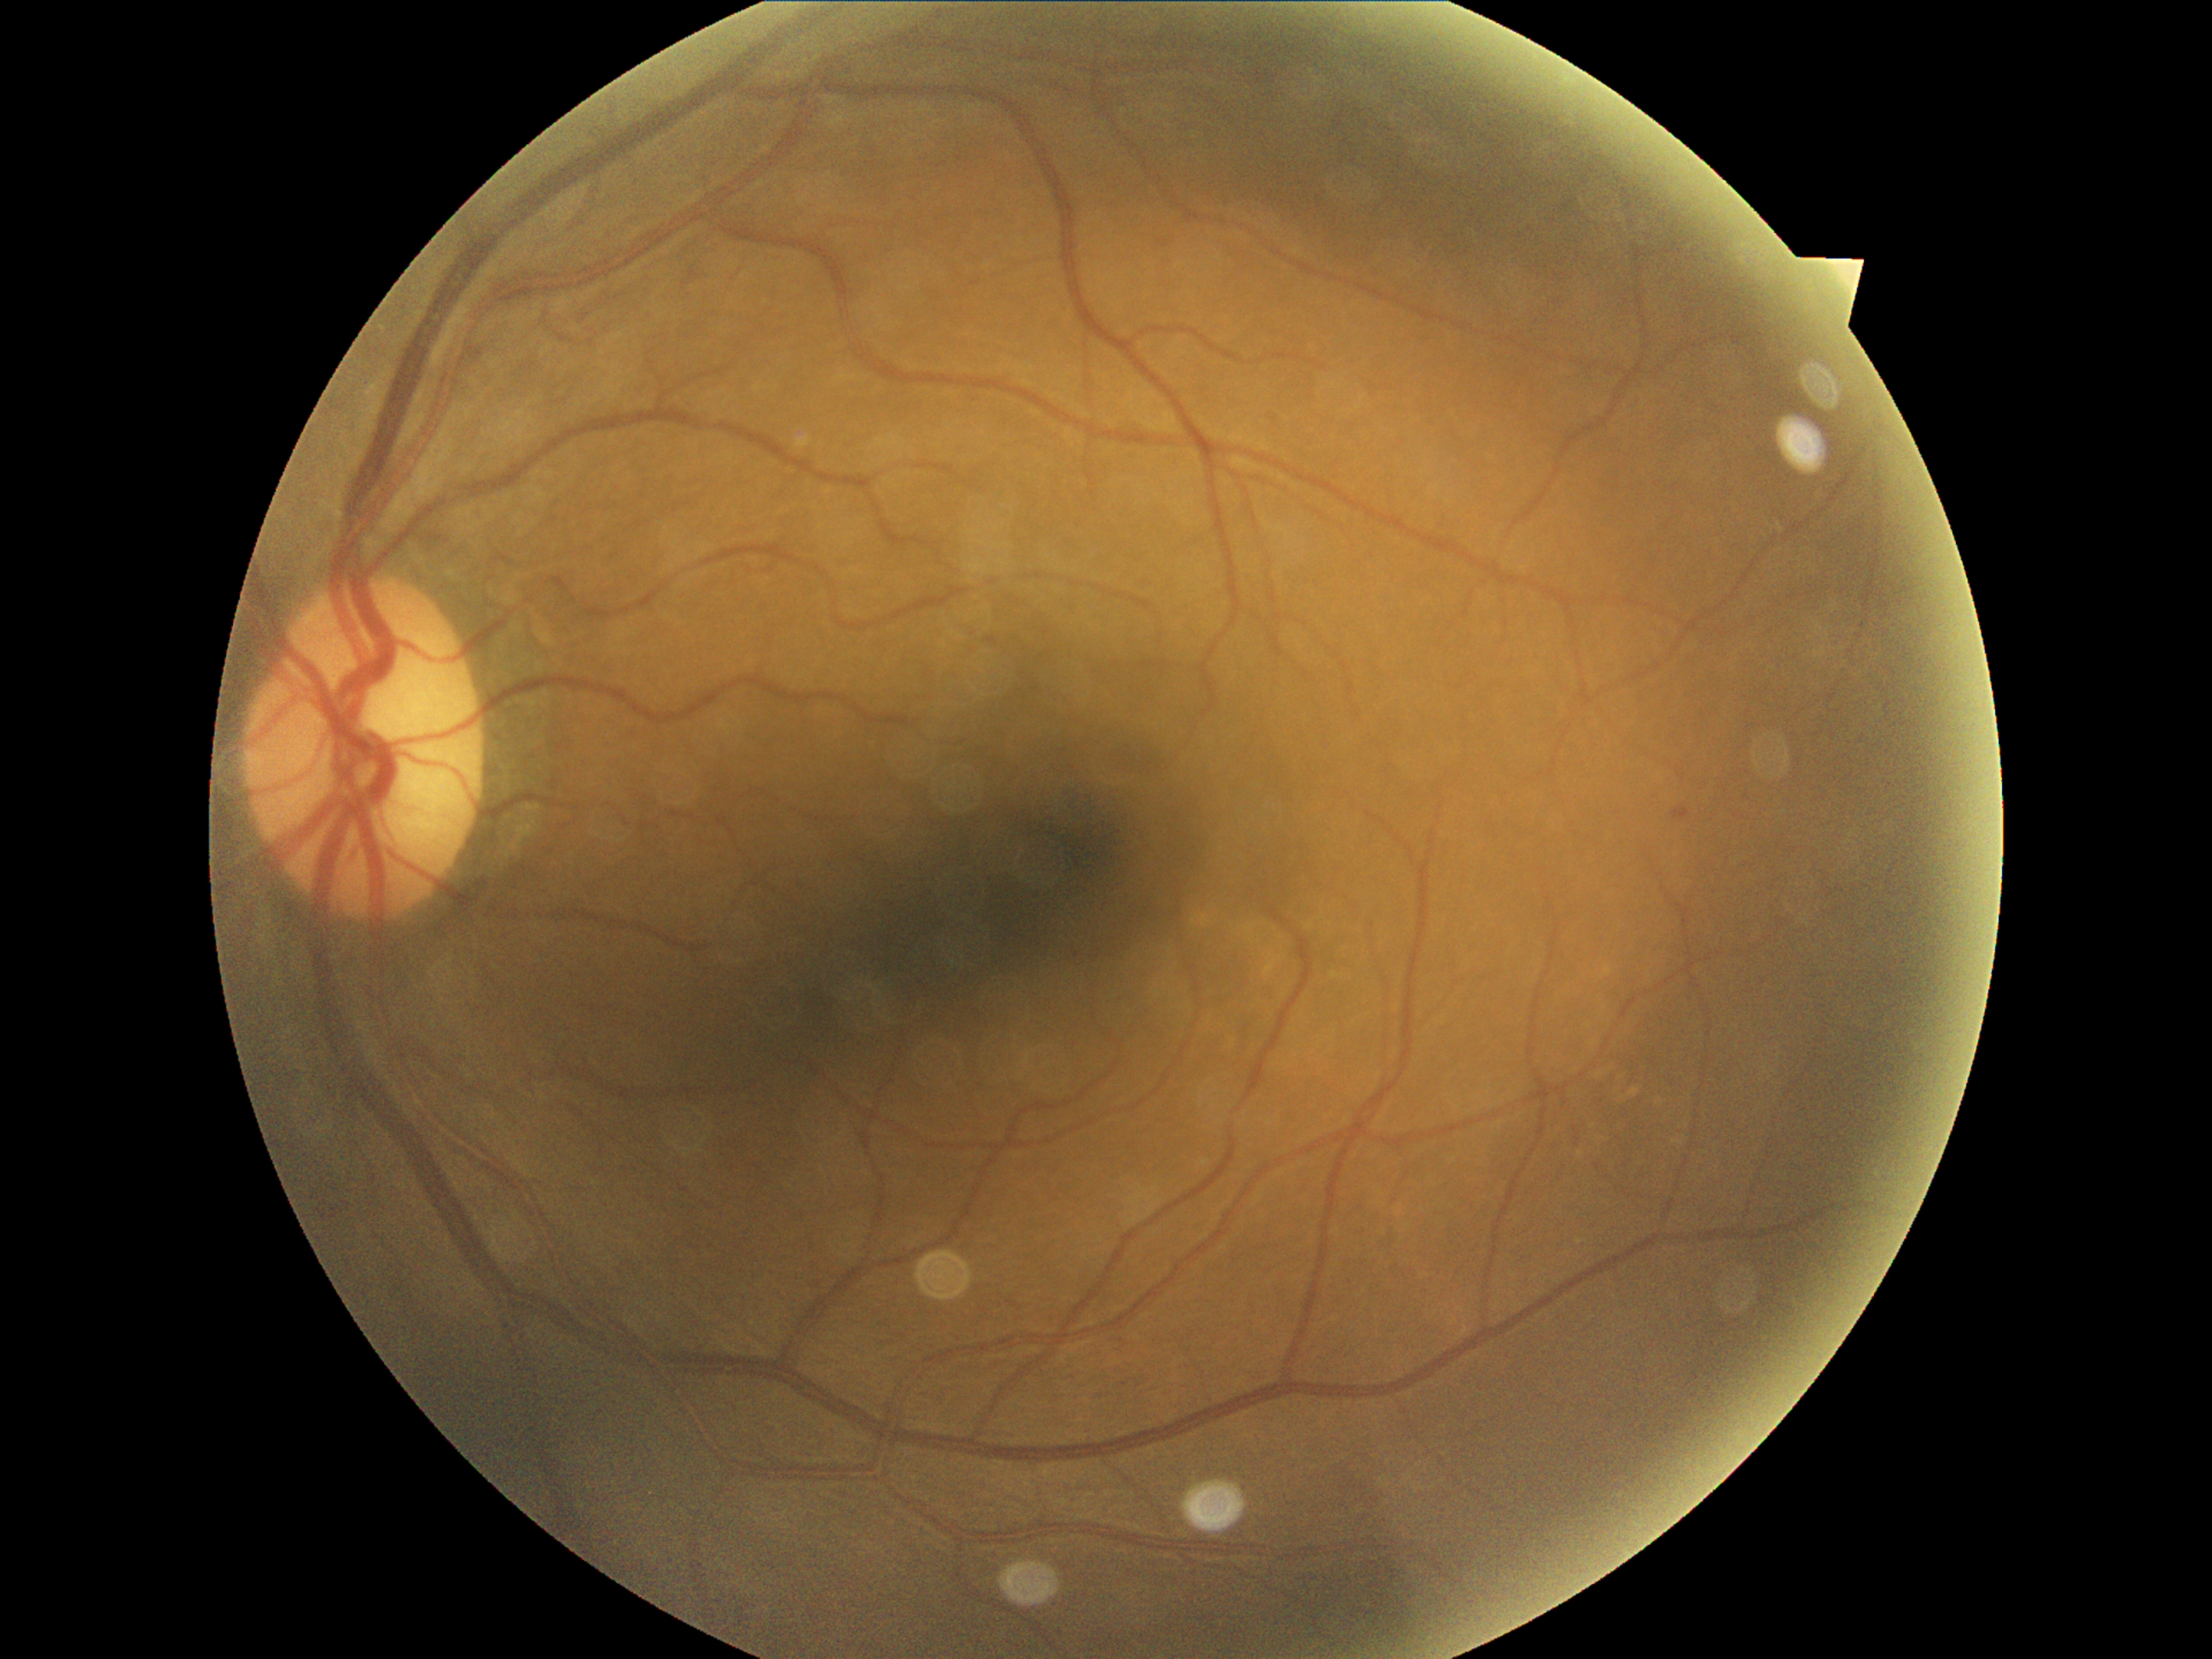

DR stage=grade 1.